Image size 640x480. Wide-field fundus photograph from neonatal ROP screening: 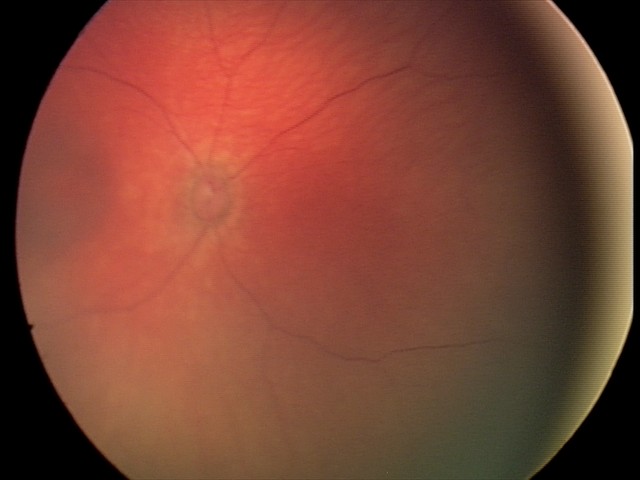

Screening series with retinal hemorrhages.